Nonmydriatic: 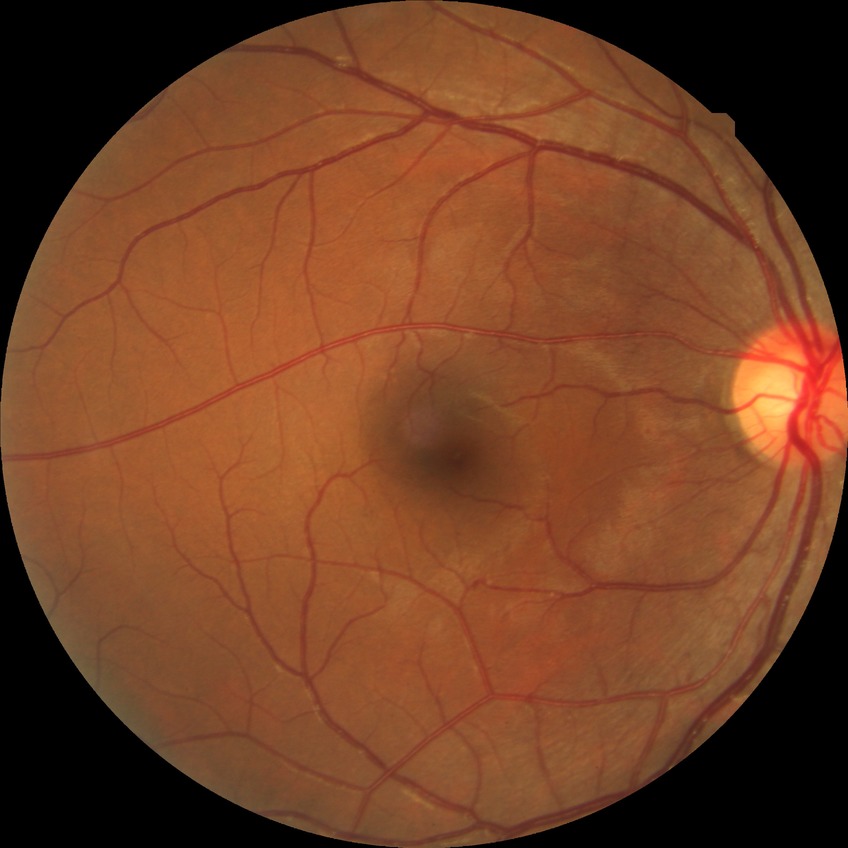

diabetic retinopathy (DR)=simple diabetic retinopathy (SDR).